Infant wide-field fundus photograph:
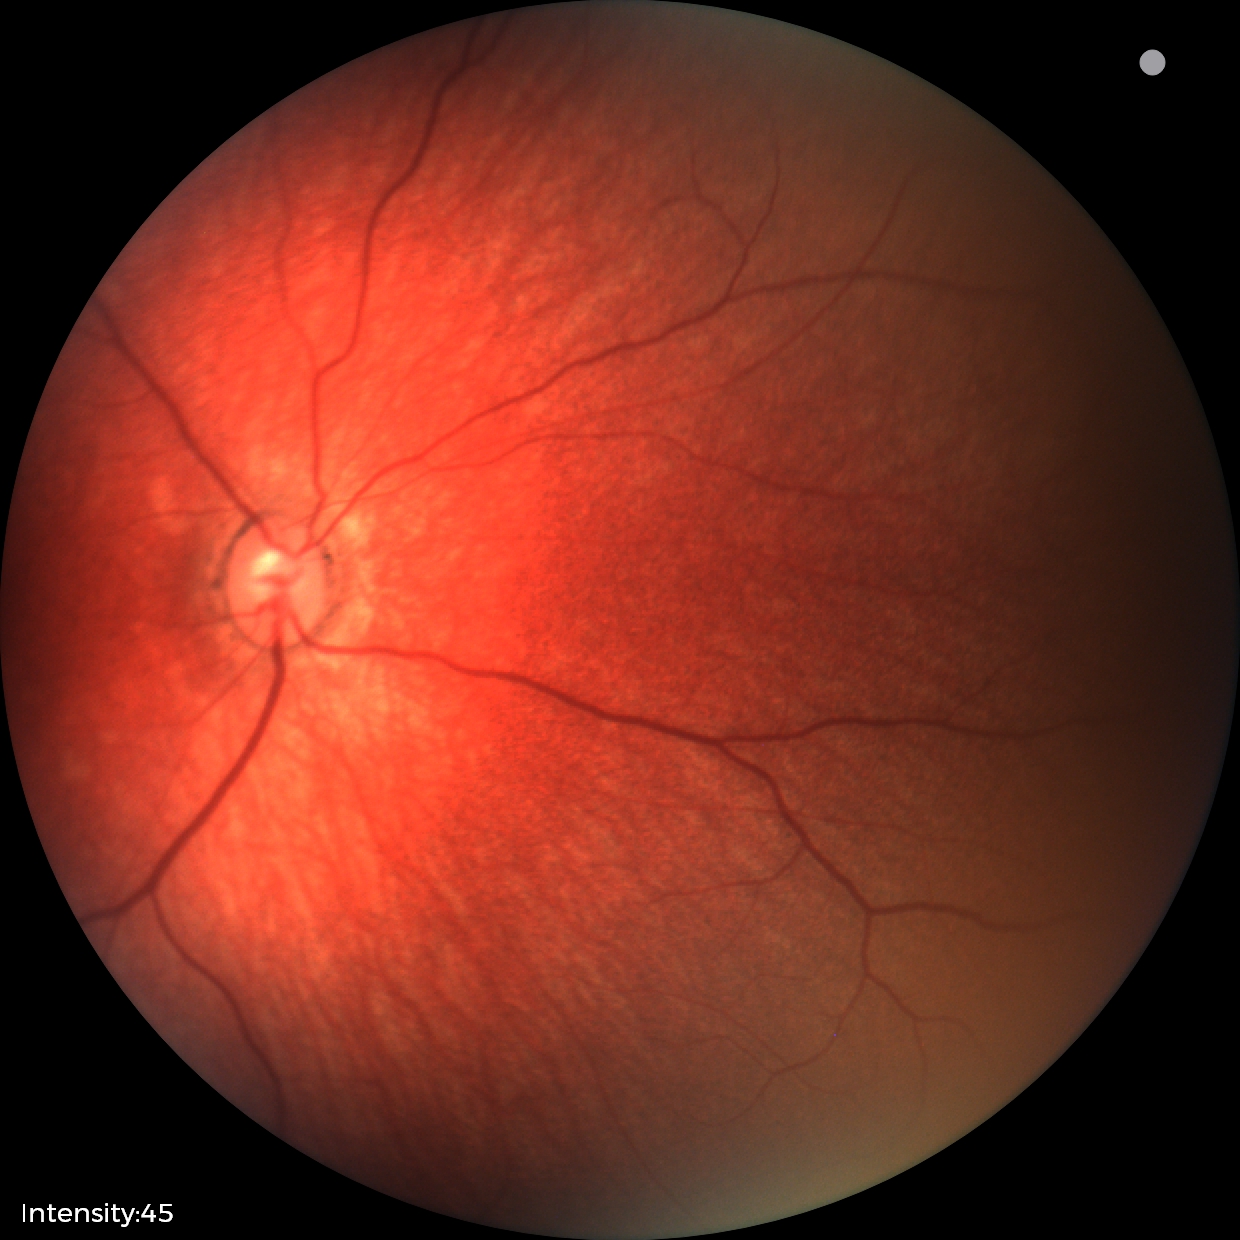
Diagnosis = physiological.